45° field of view: 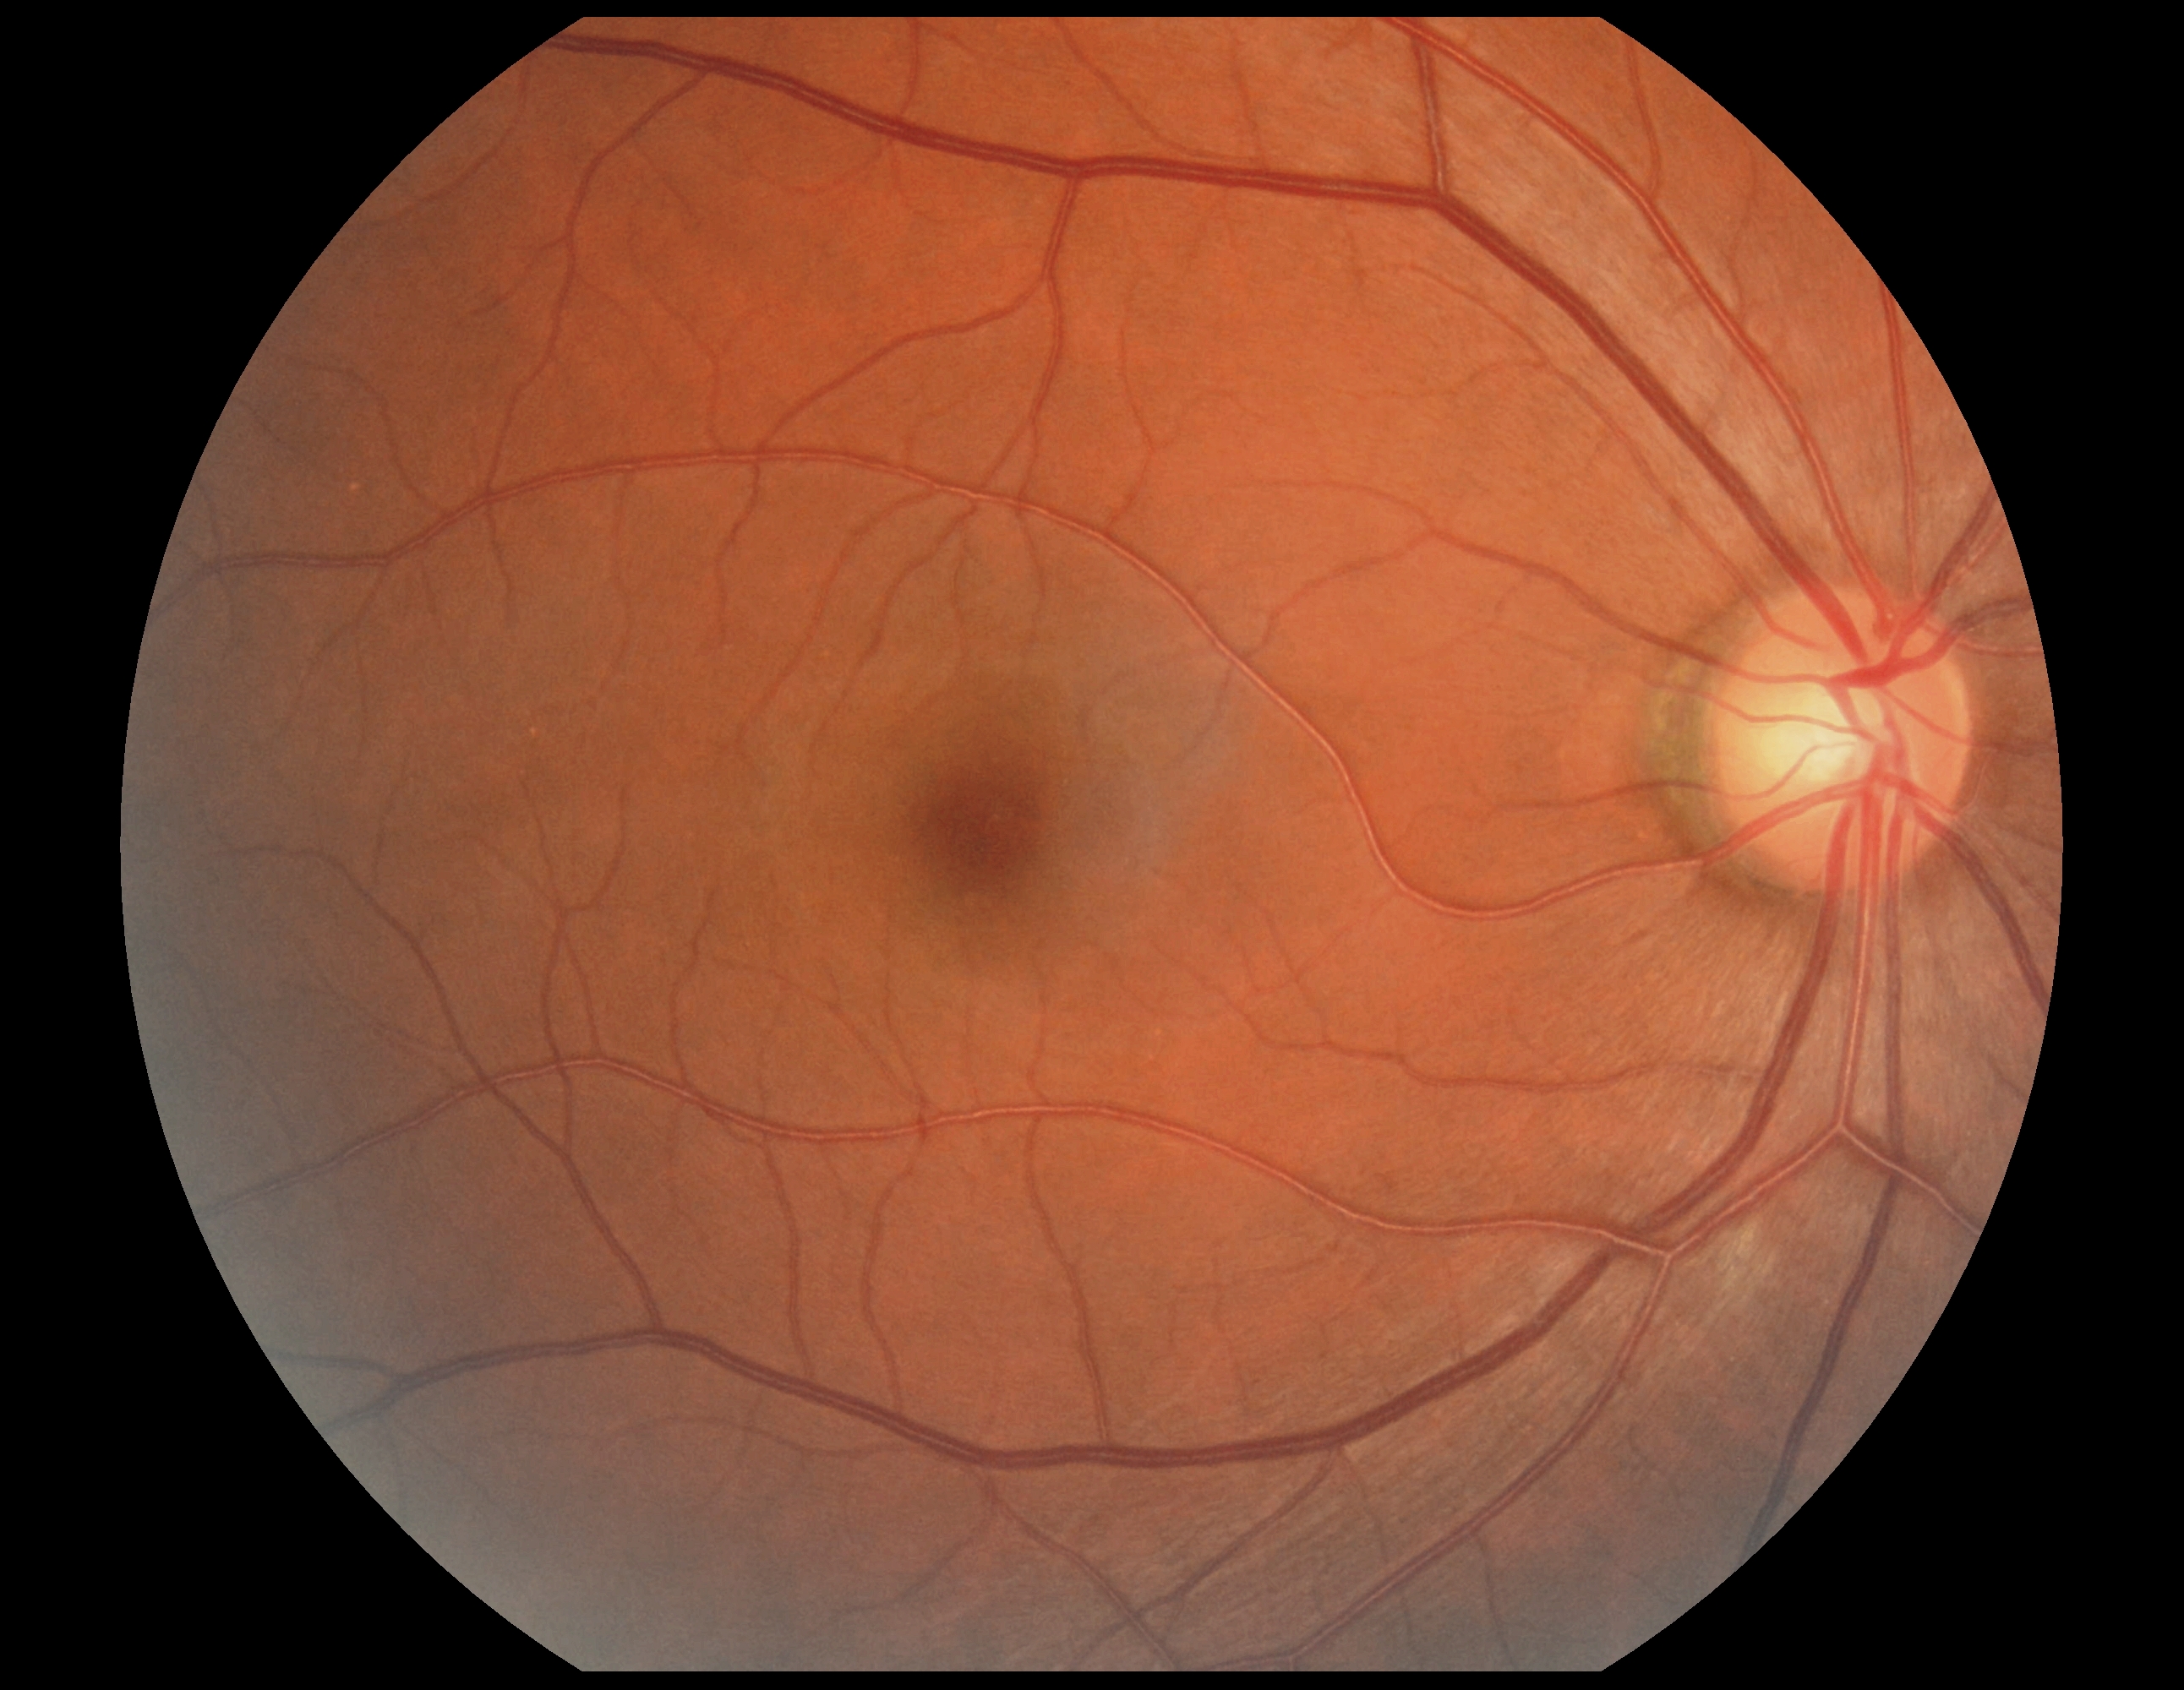 DR: 0/4.